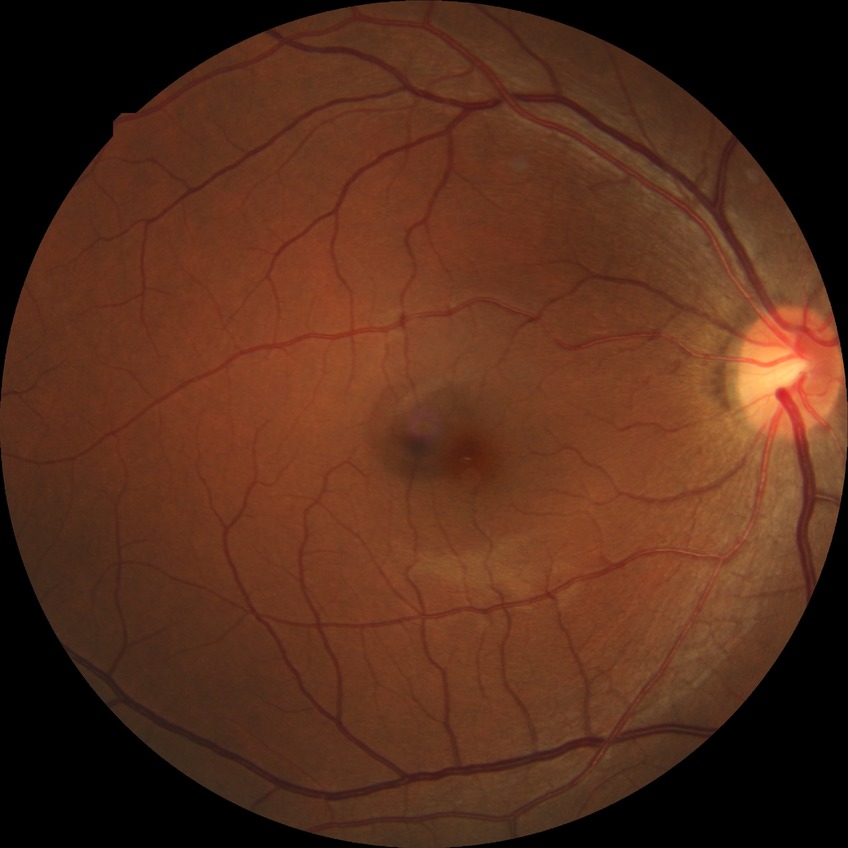 Diabetic retinopathy (DR) is no diabetic retinopathy (NDR).